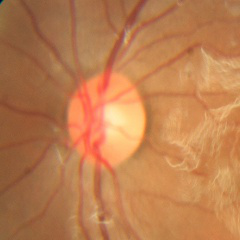

There is evidence of no glaucoma.